45-degree field of view:
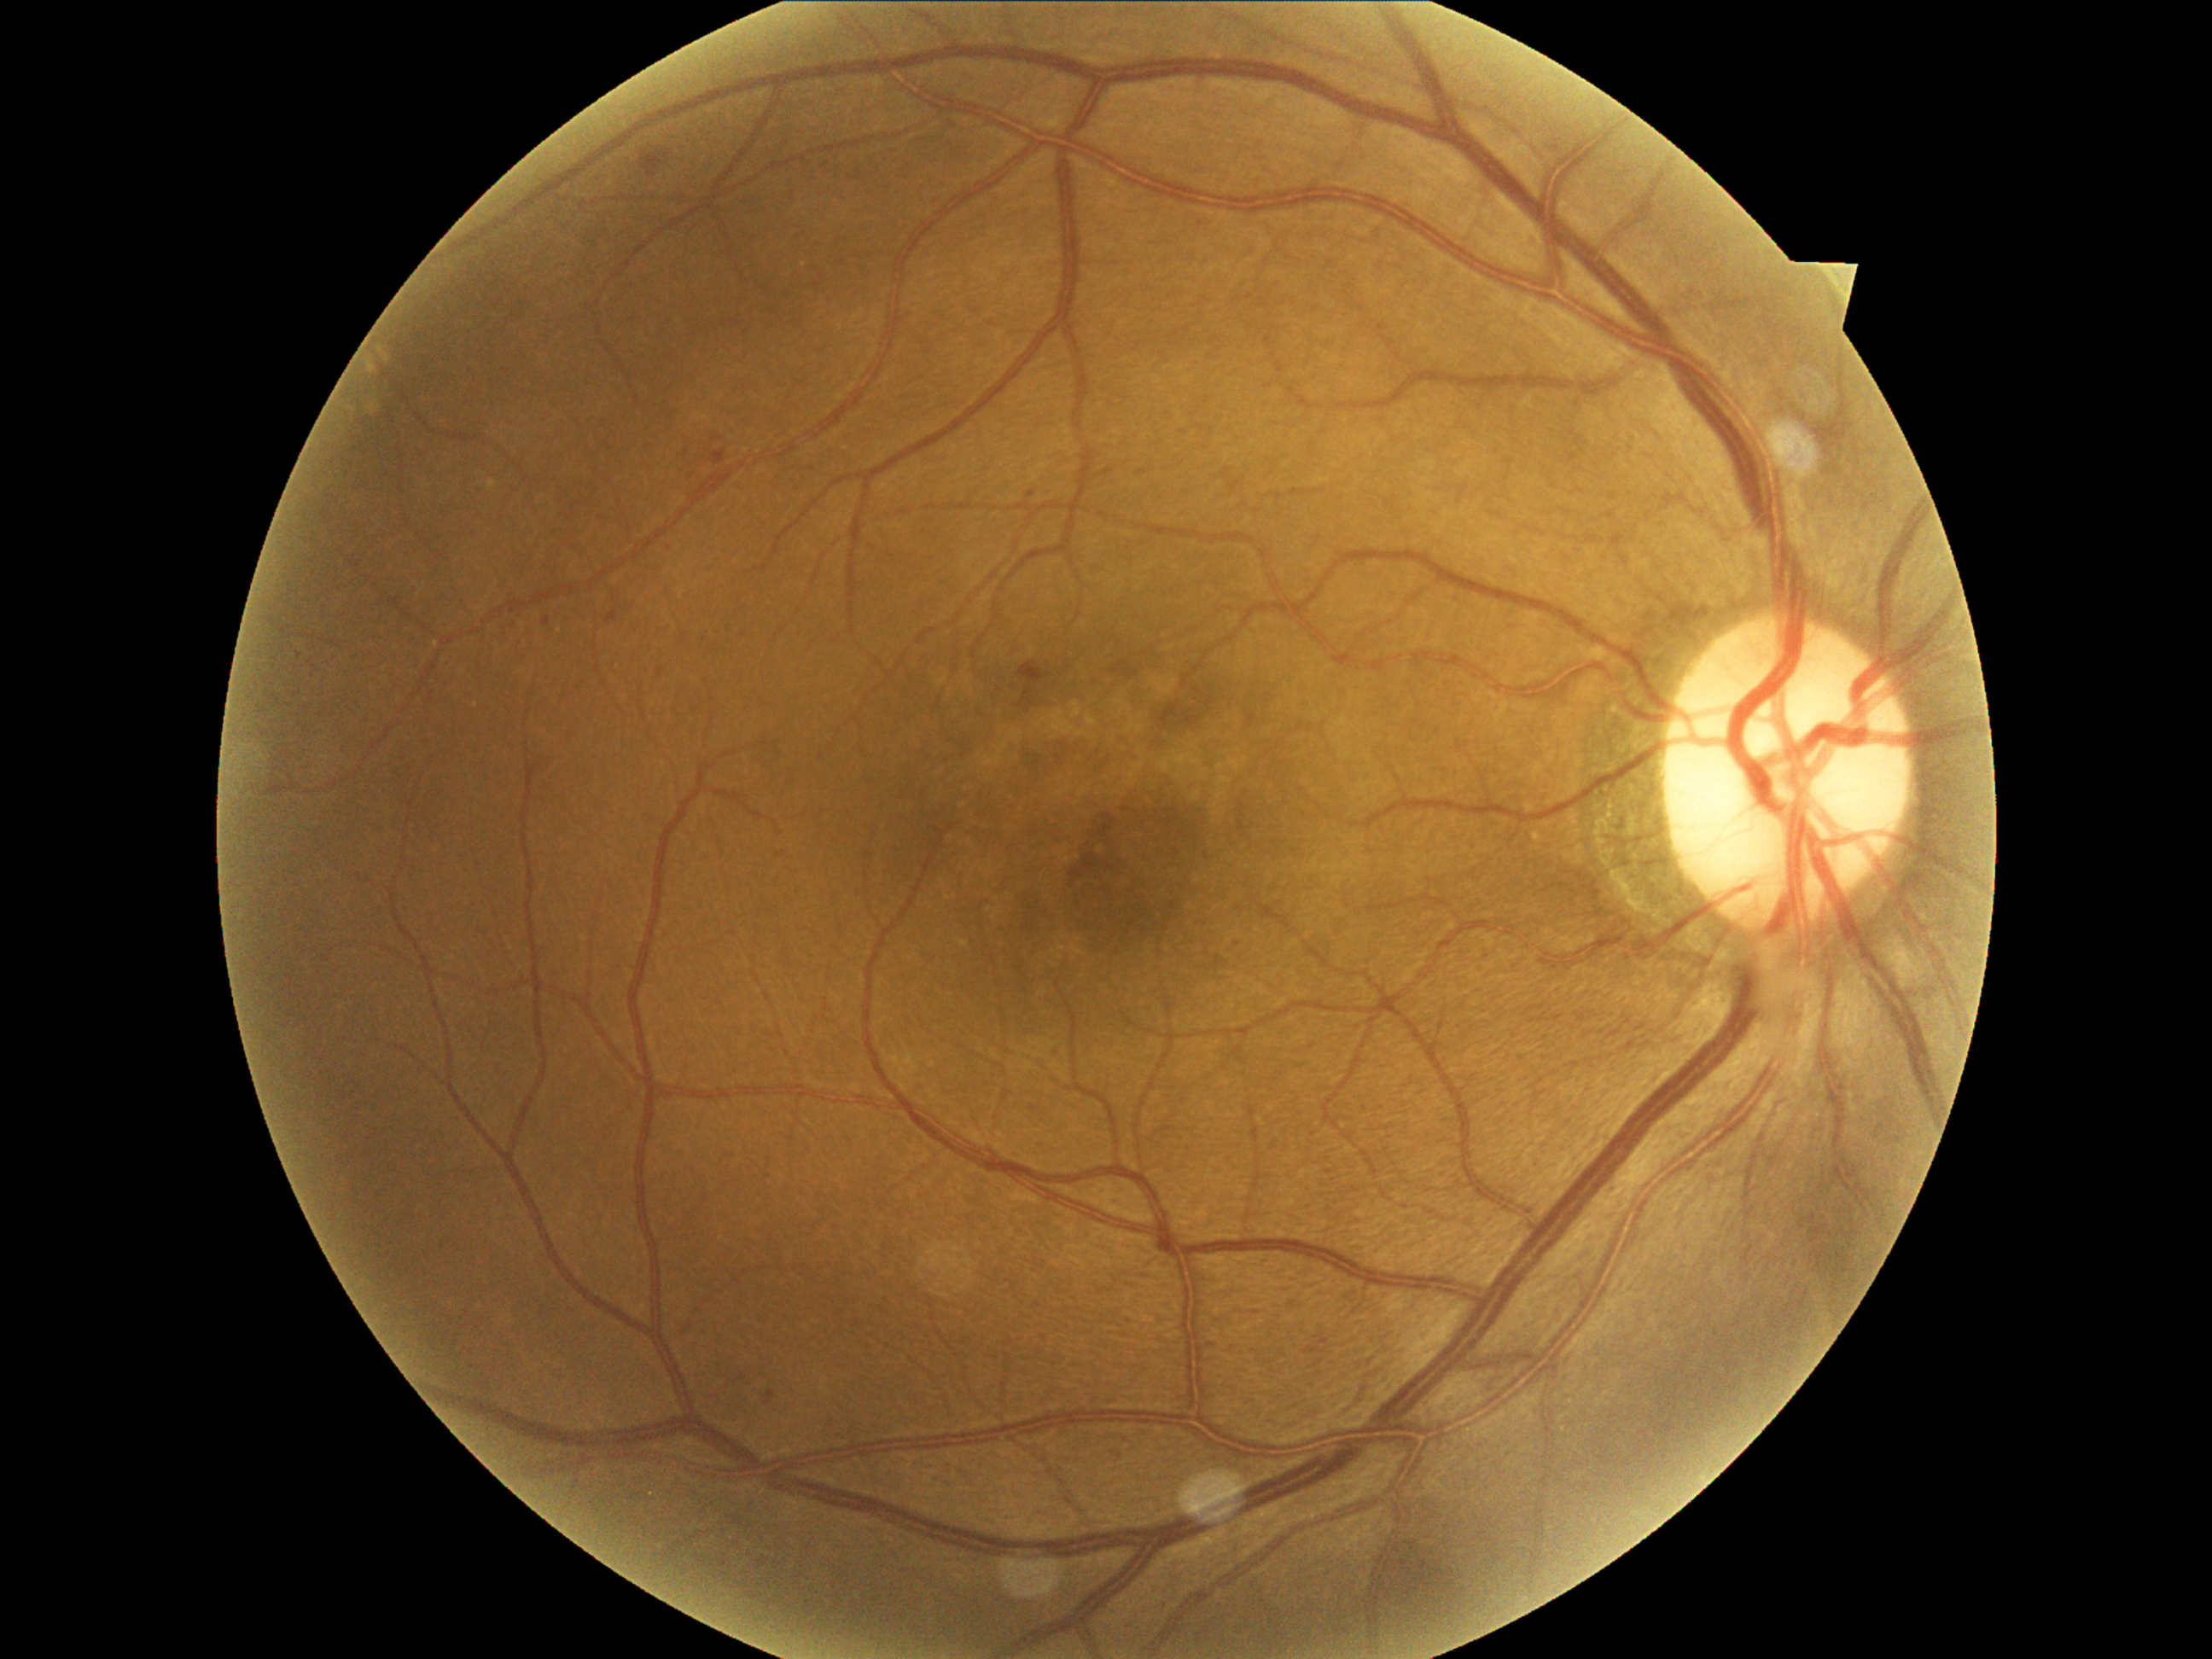
Retinopathy: grade 2 (moderate NPDR) — more than just microaneurysms but less than severe NPDR
soft exudates: not present
microaneurysms: [1027,492,1035,499] | [854,1320,864,1327] | [607,610,619,624] | [1214,955,1228,969] | [542,617,550,627] | [1322,1170,1332,1173] | [711,450,726,465] | [764,1392,777,1406]
Small microaneurysms approximately at <pt>669,548</pt> | <pt>687,452</pt>
hard exudates: not present
hemorrhages: [1404,1545,1469,1605] | [1018,663,1049,685] | [641,151,670,178]